Fundus photo:
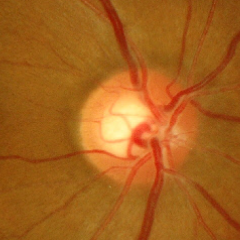

Glaucomatous changes are present. Optic disc appearance consistent with early glaucomatous optic neuropathy.